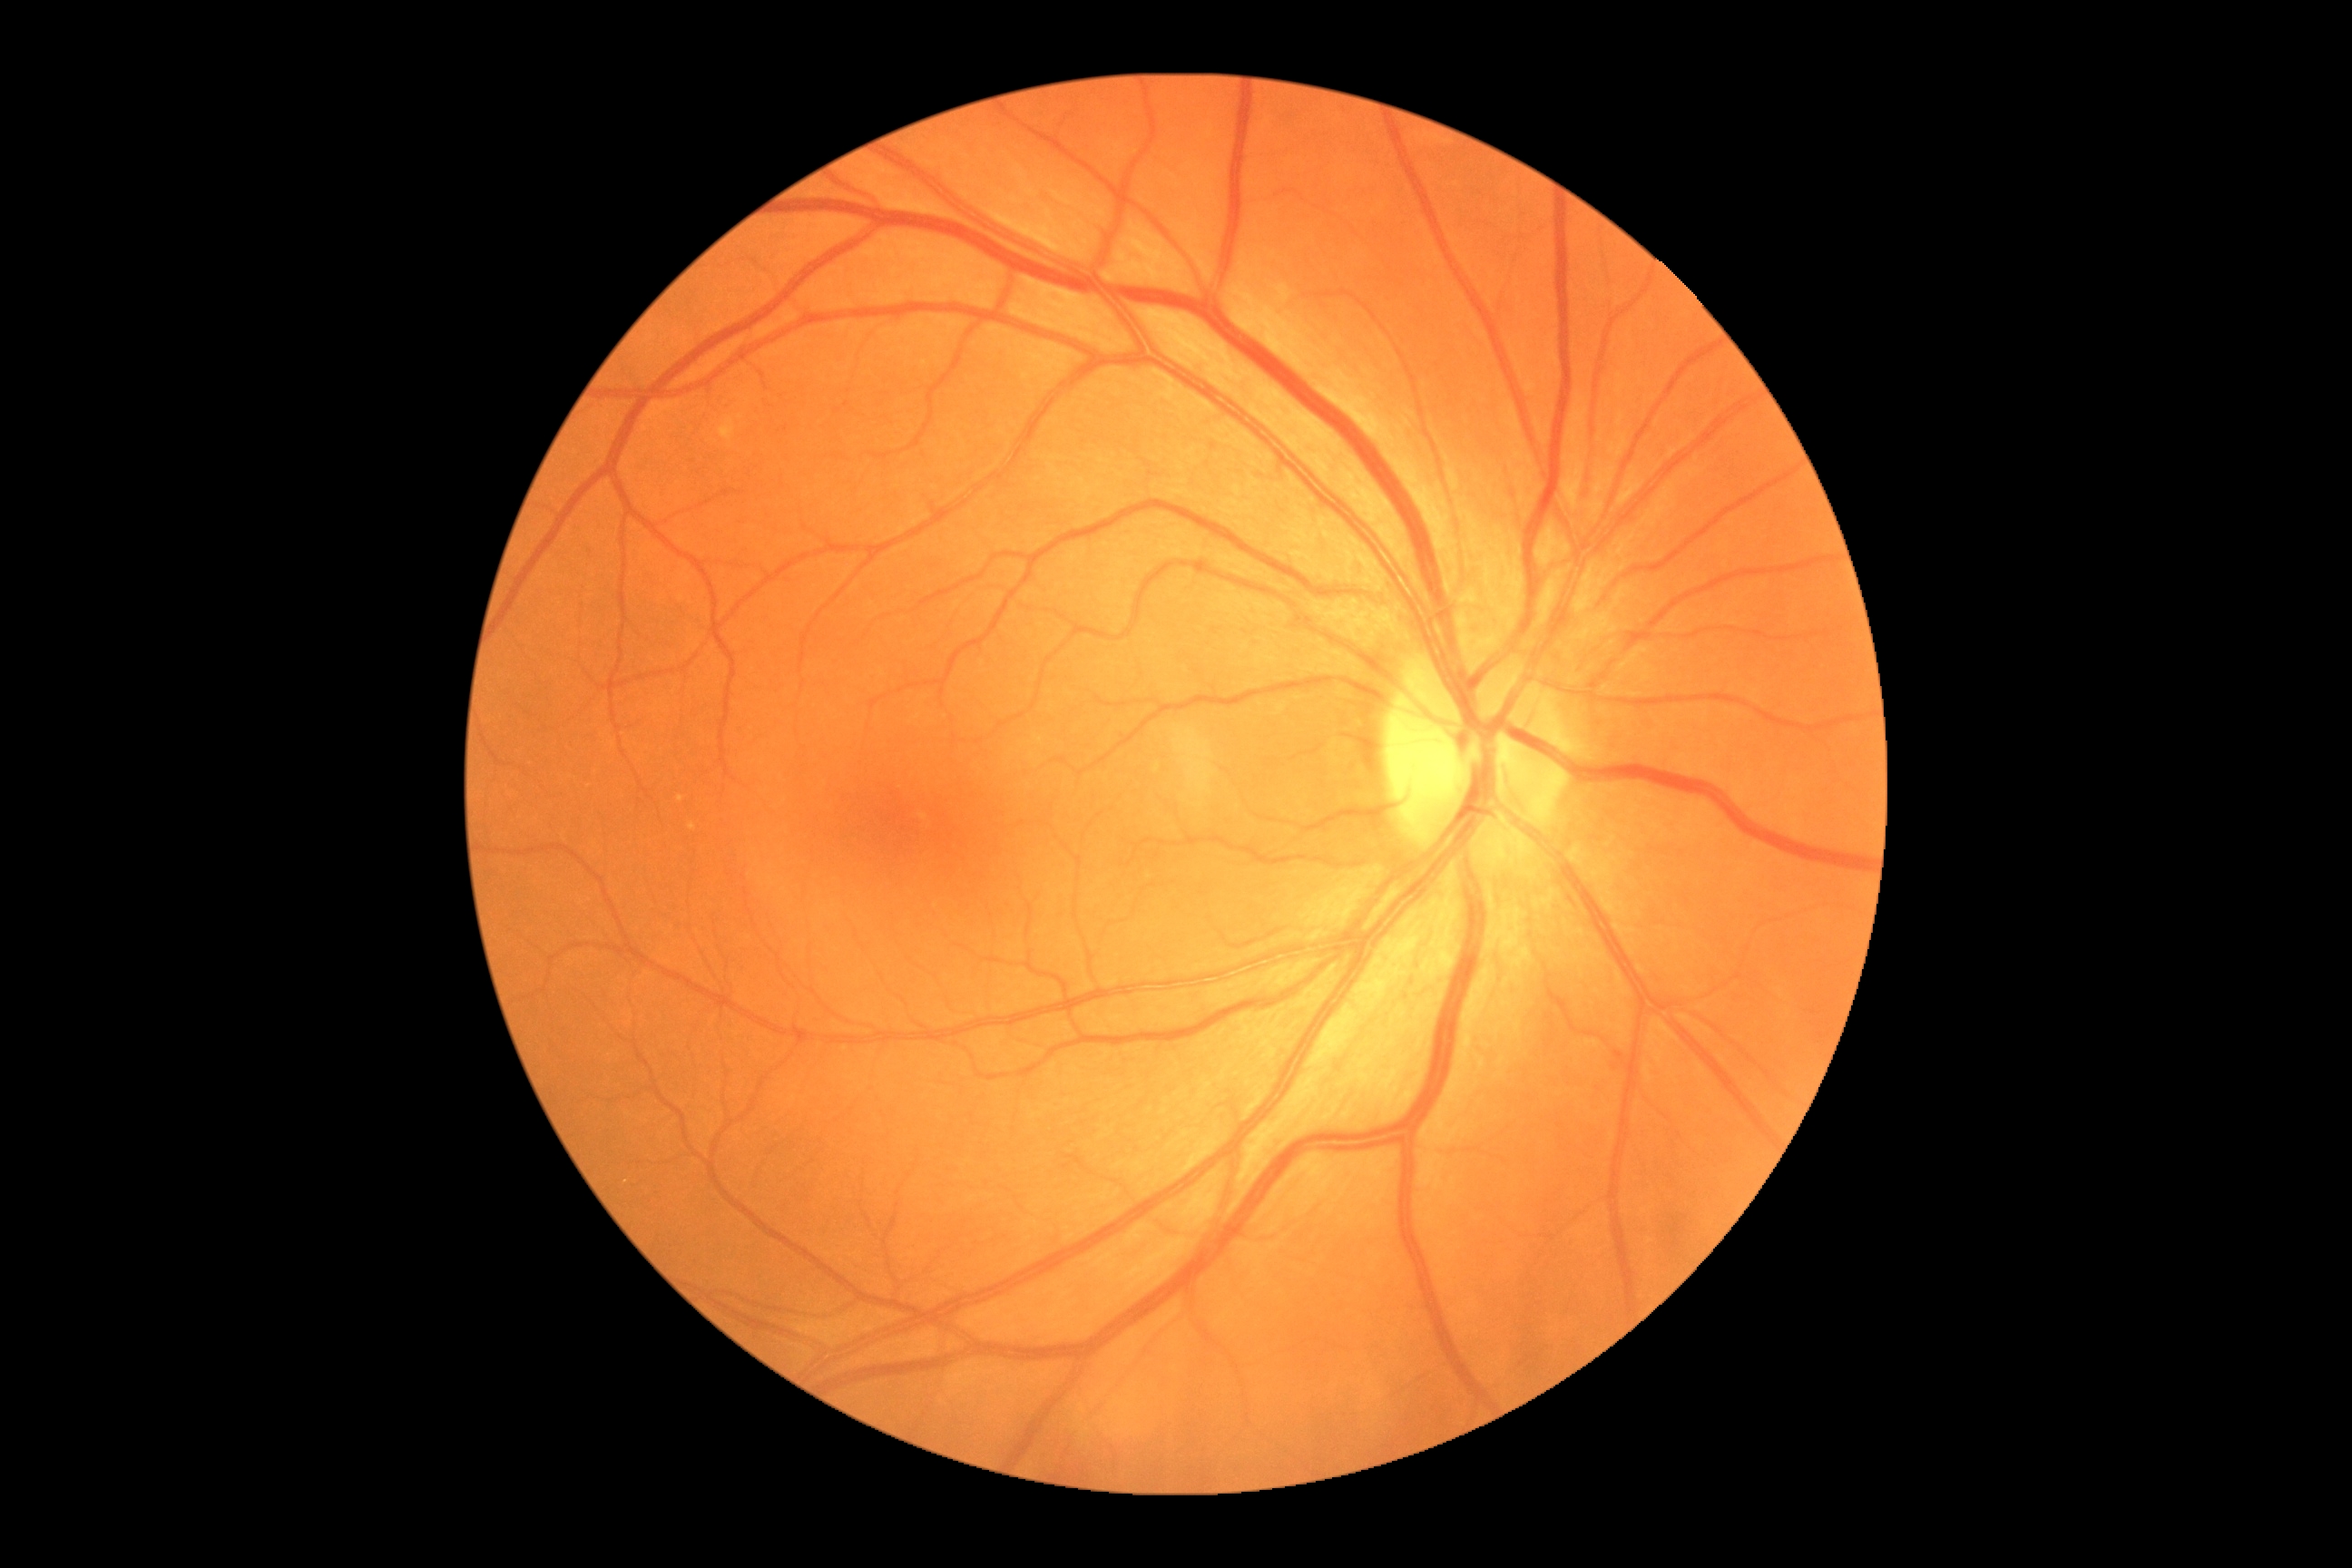

Retinopathy grade: 0 (no apparent retinopathy).